Ultra-widefield fundus mosaic — 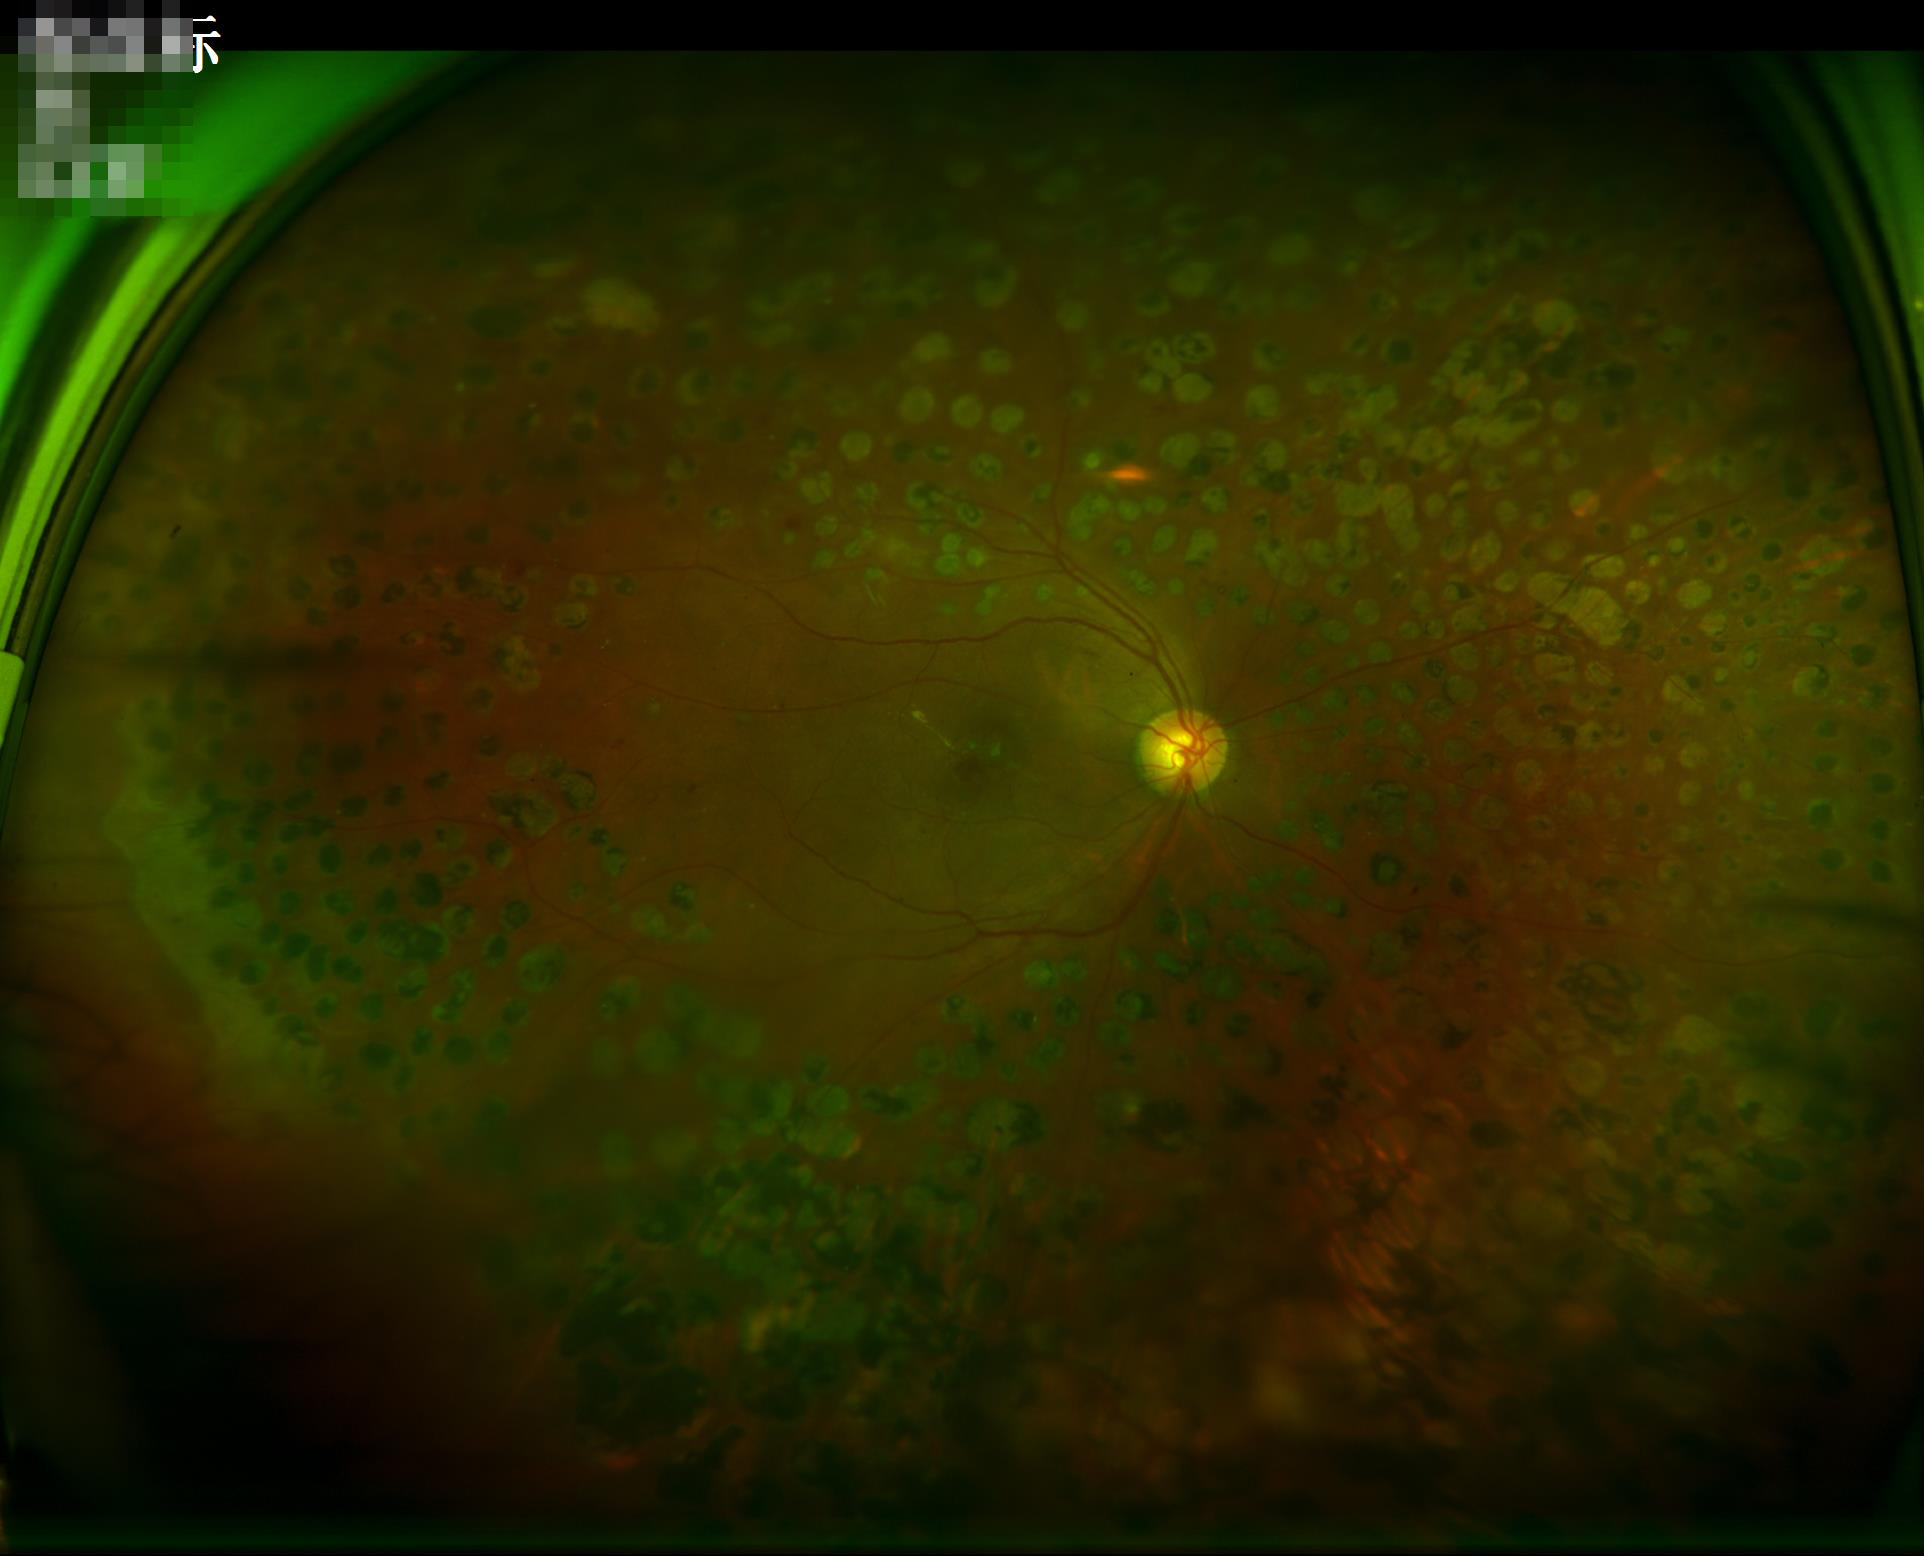 Poor illumination with uneven exposure. The image is clear. Contrast is good.